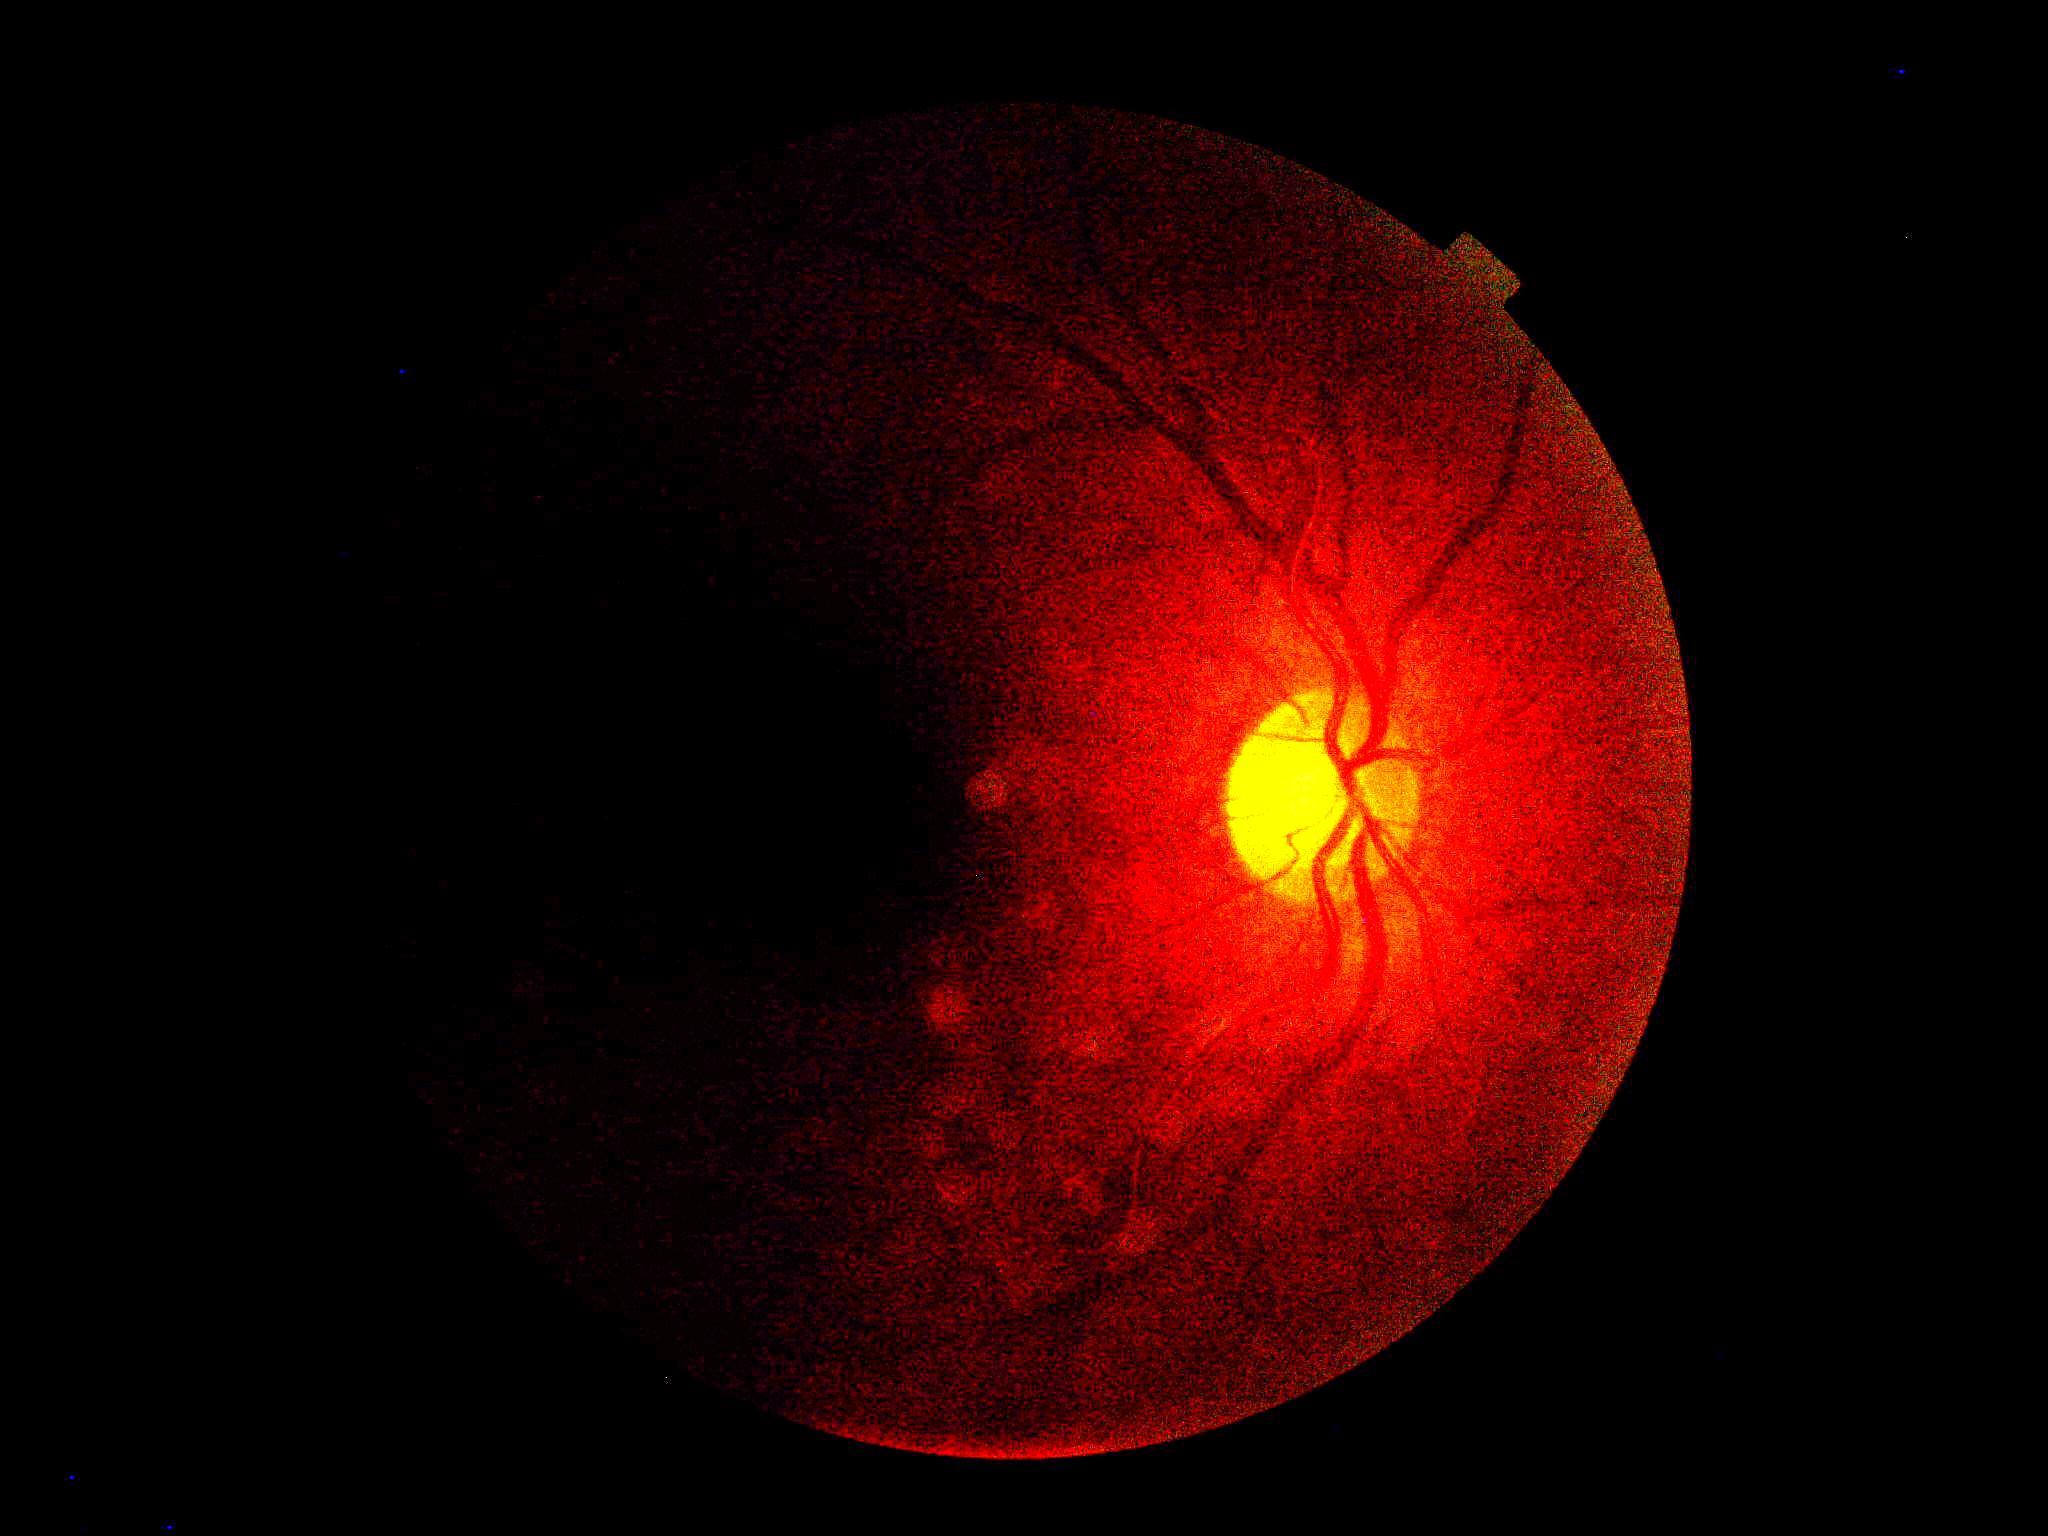 Retinopathy is ungradable.
Quality too poor to assess for DR.